Diabetic retinopathy graded by the modified Davis classification; 848x848; without pupil dilation: 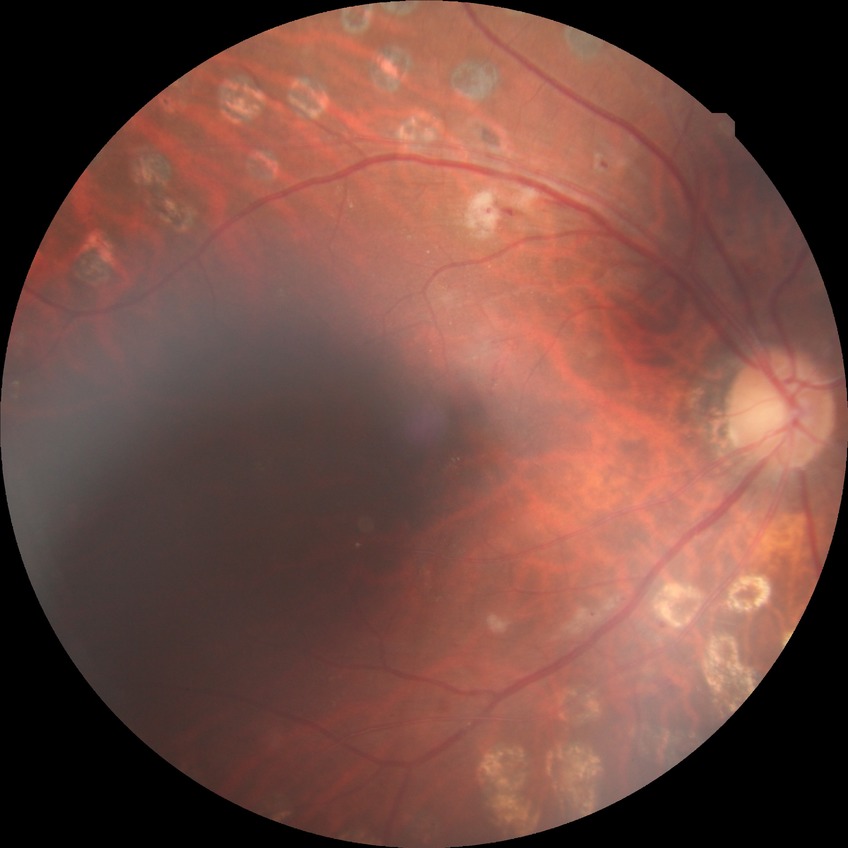 {
  "davis_grade": "proliferative diabetic retinopathy"
}